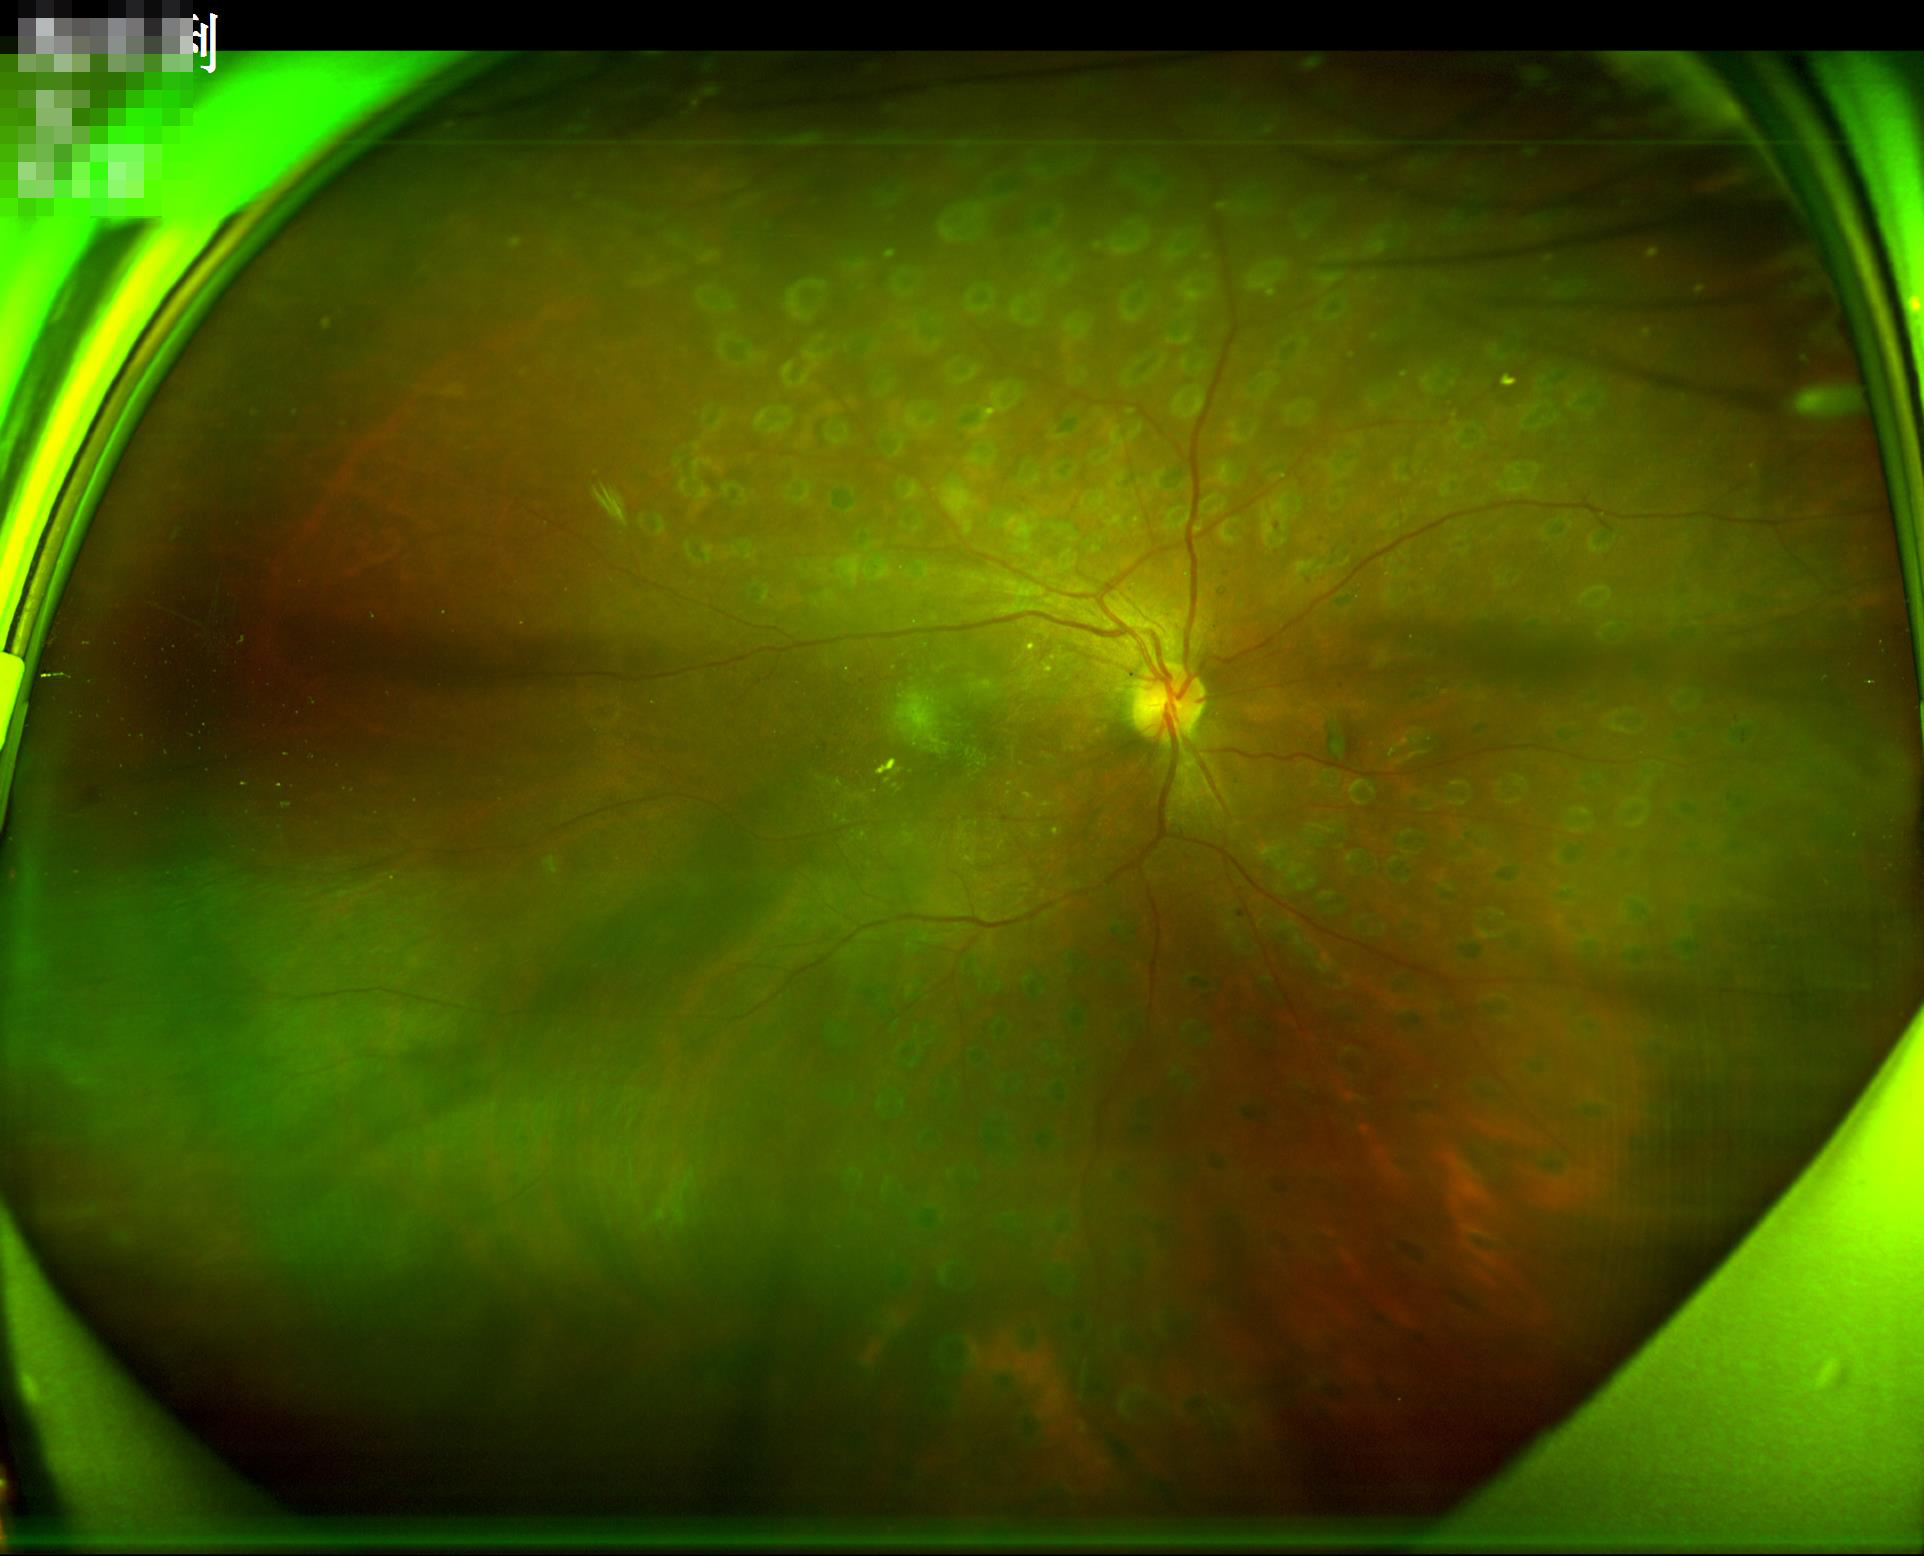
Illumination/color: no over- or under-exposure; Focus: sharp throughout the field; Overall quality: good and suitable for diagnostic use.